Field includes the optic disc and macula. Camera: Topcon TRC-50DX. Color fundus photograph. Captured after pupil dilation. 50° FOV. 2228 by 1652 pixels
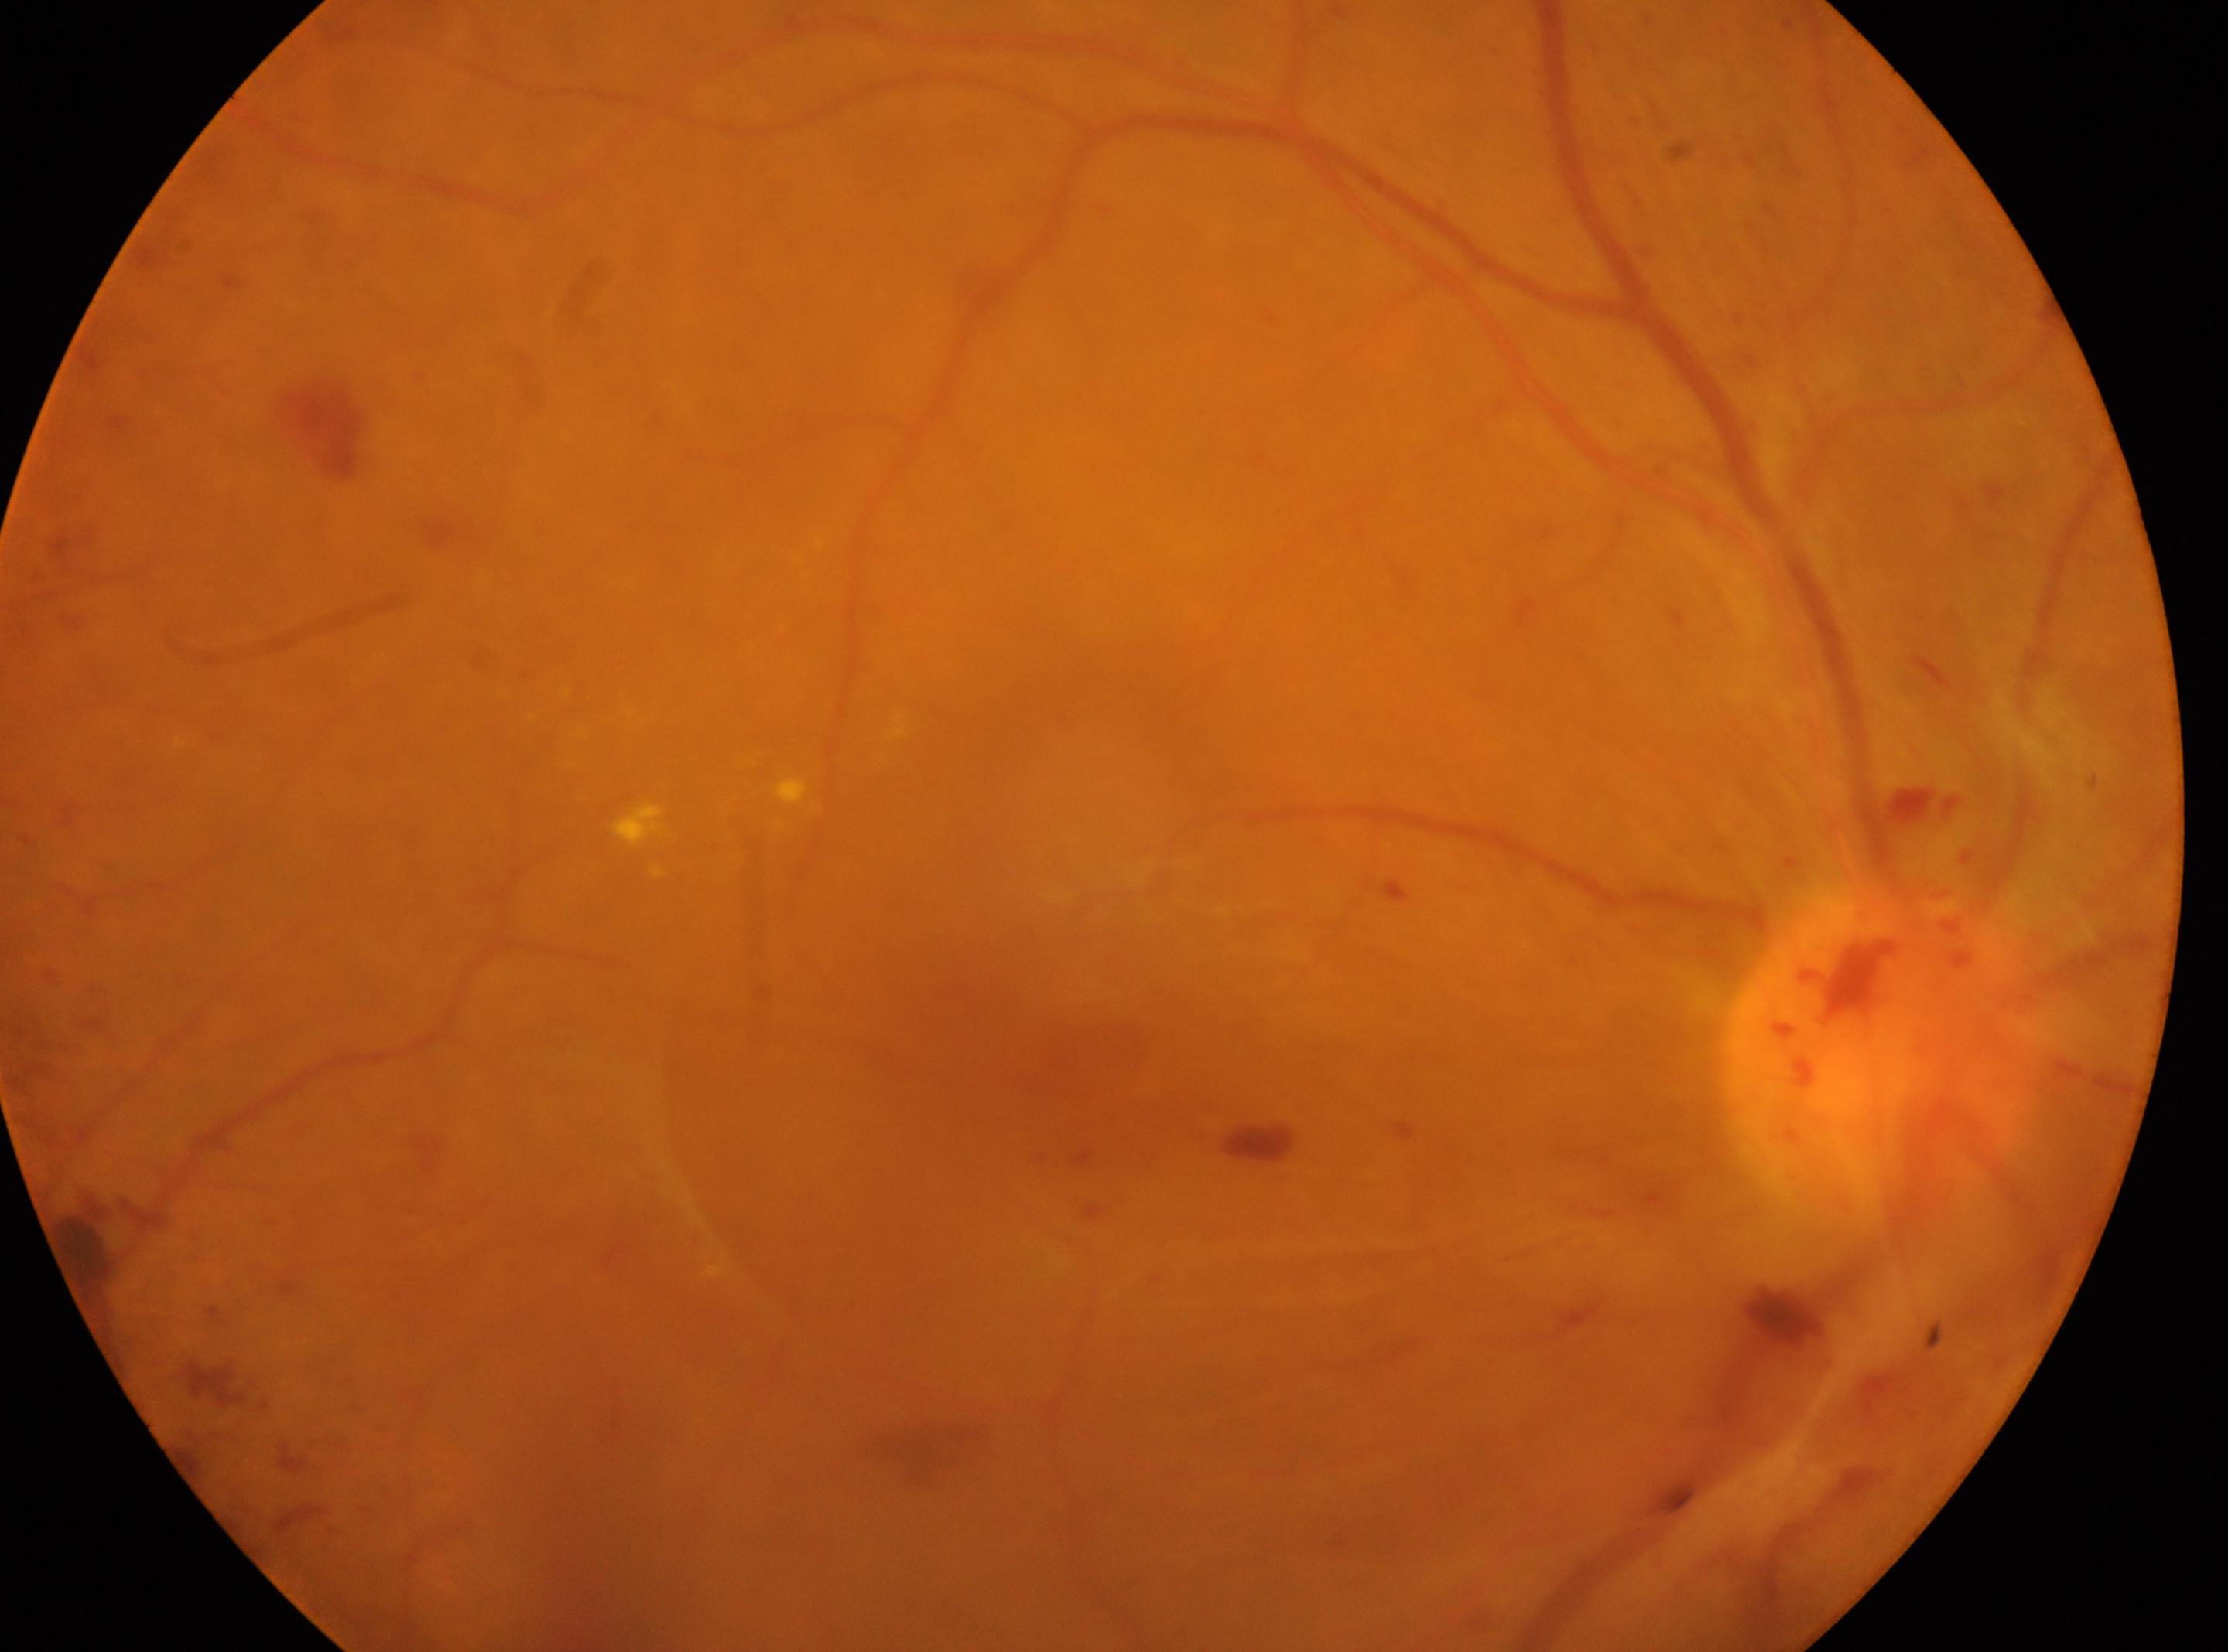
Findings:
- macular center — (1077,1046)
- DR stage — proliferative diabetic retinopathy (grade 4)
- the optic disc — (1879,1058)
- laterality — right eye